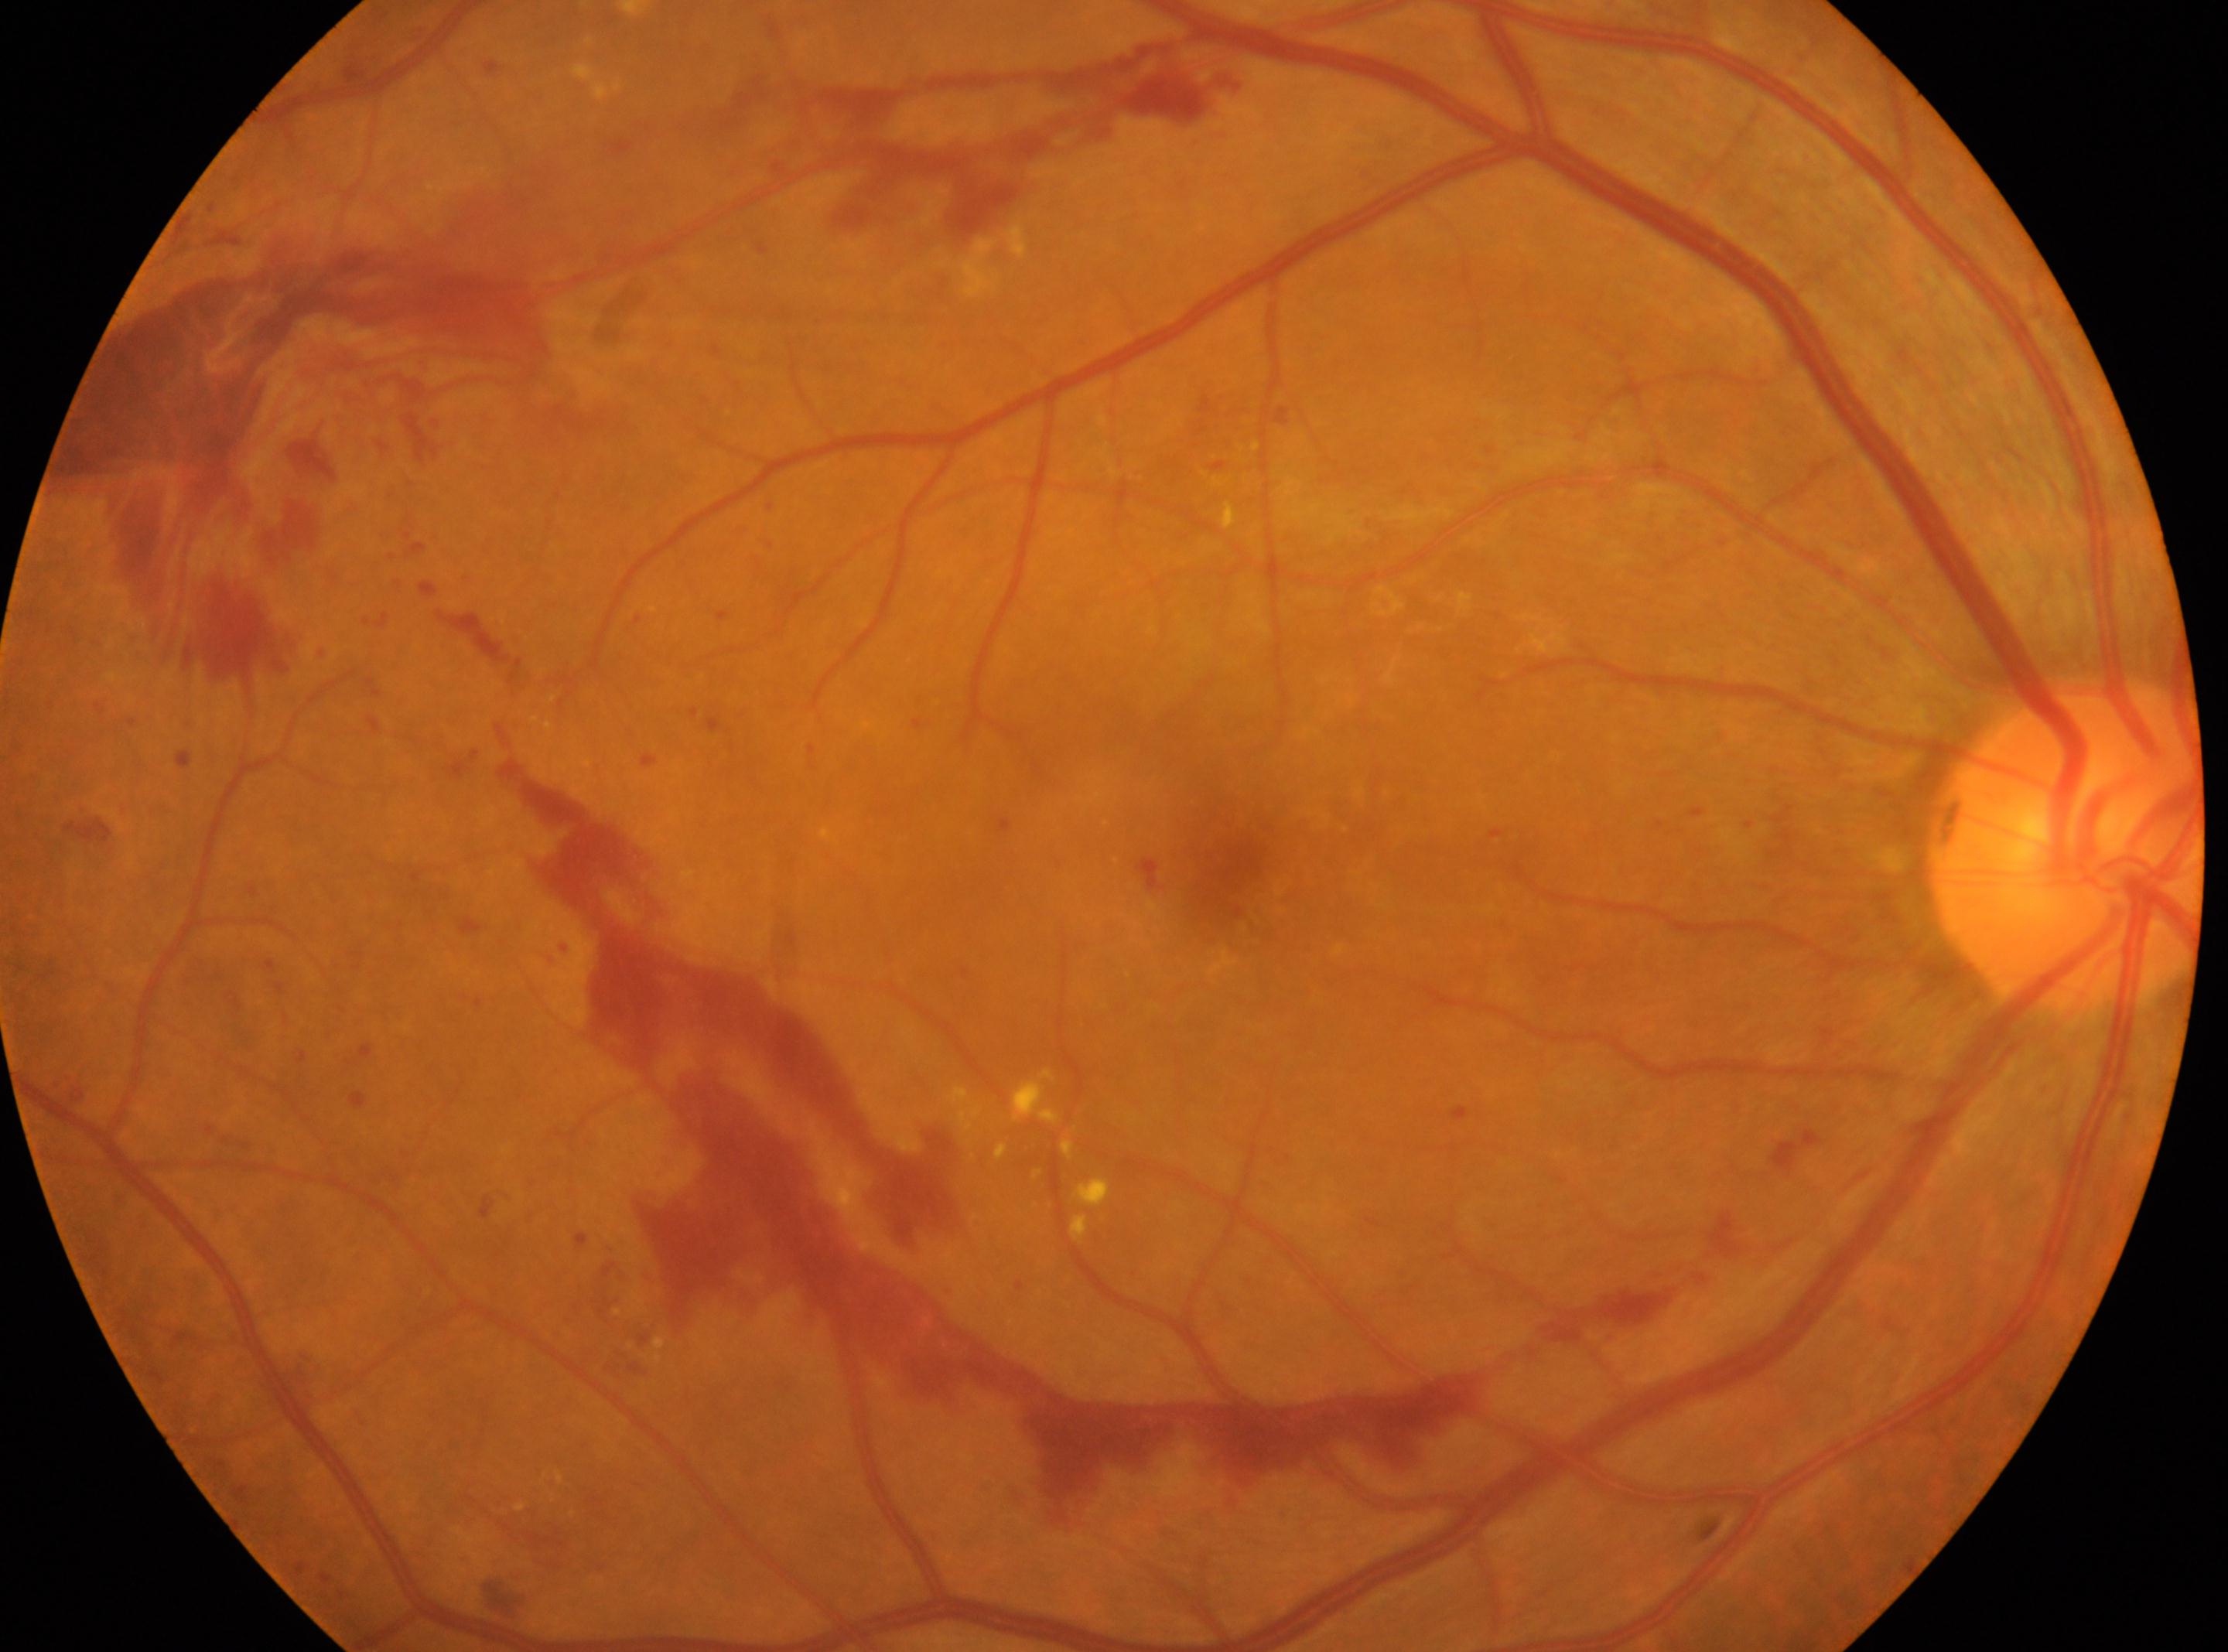

{"optic_disc": "x=2065, y=843", "fovea": "x=1211, y=882", "eye": "oculus dexter", "dr_grade": "4 (PDR)"}